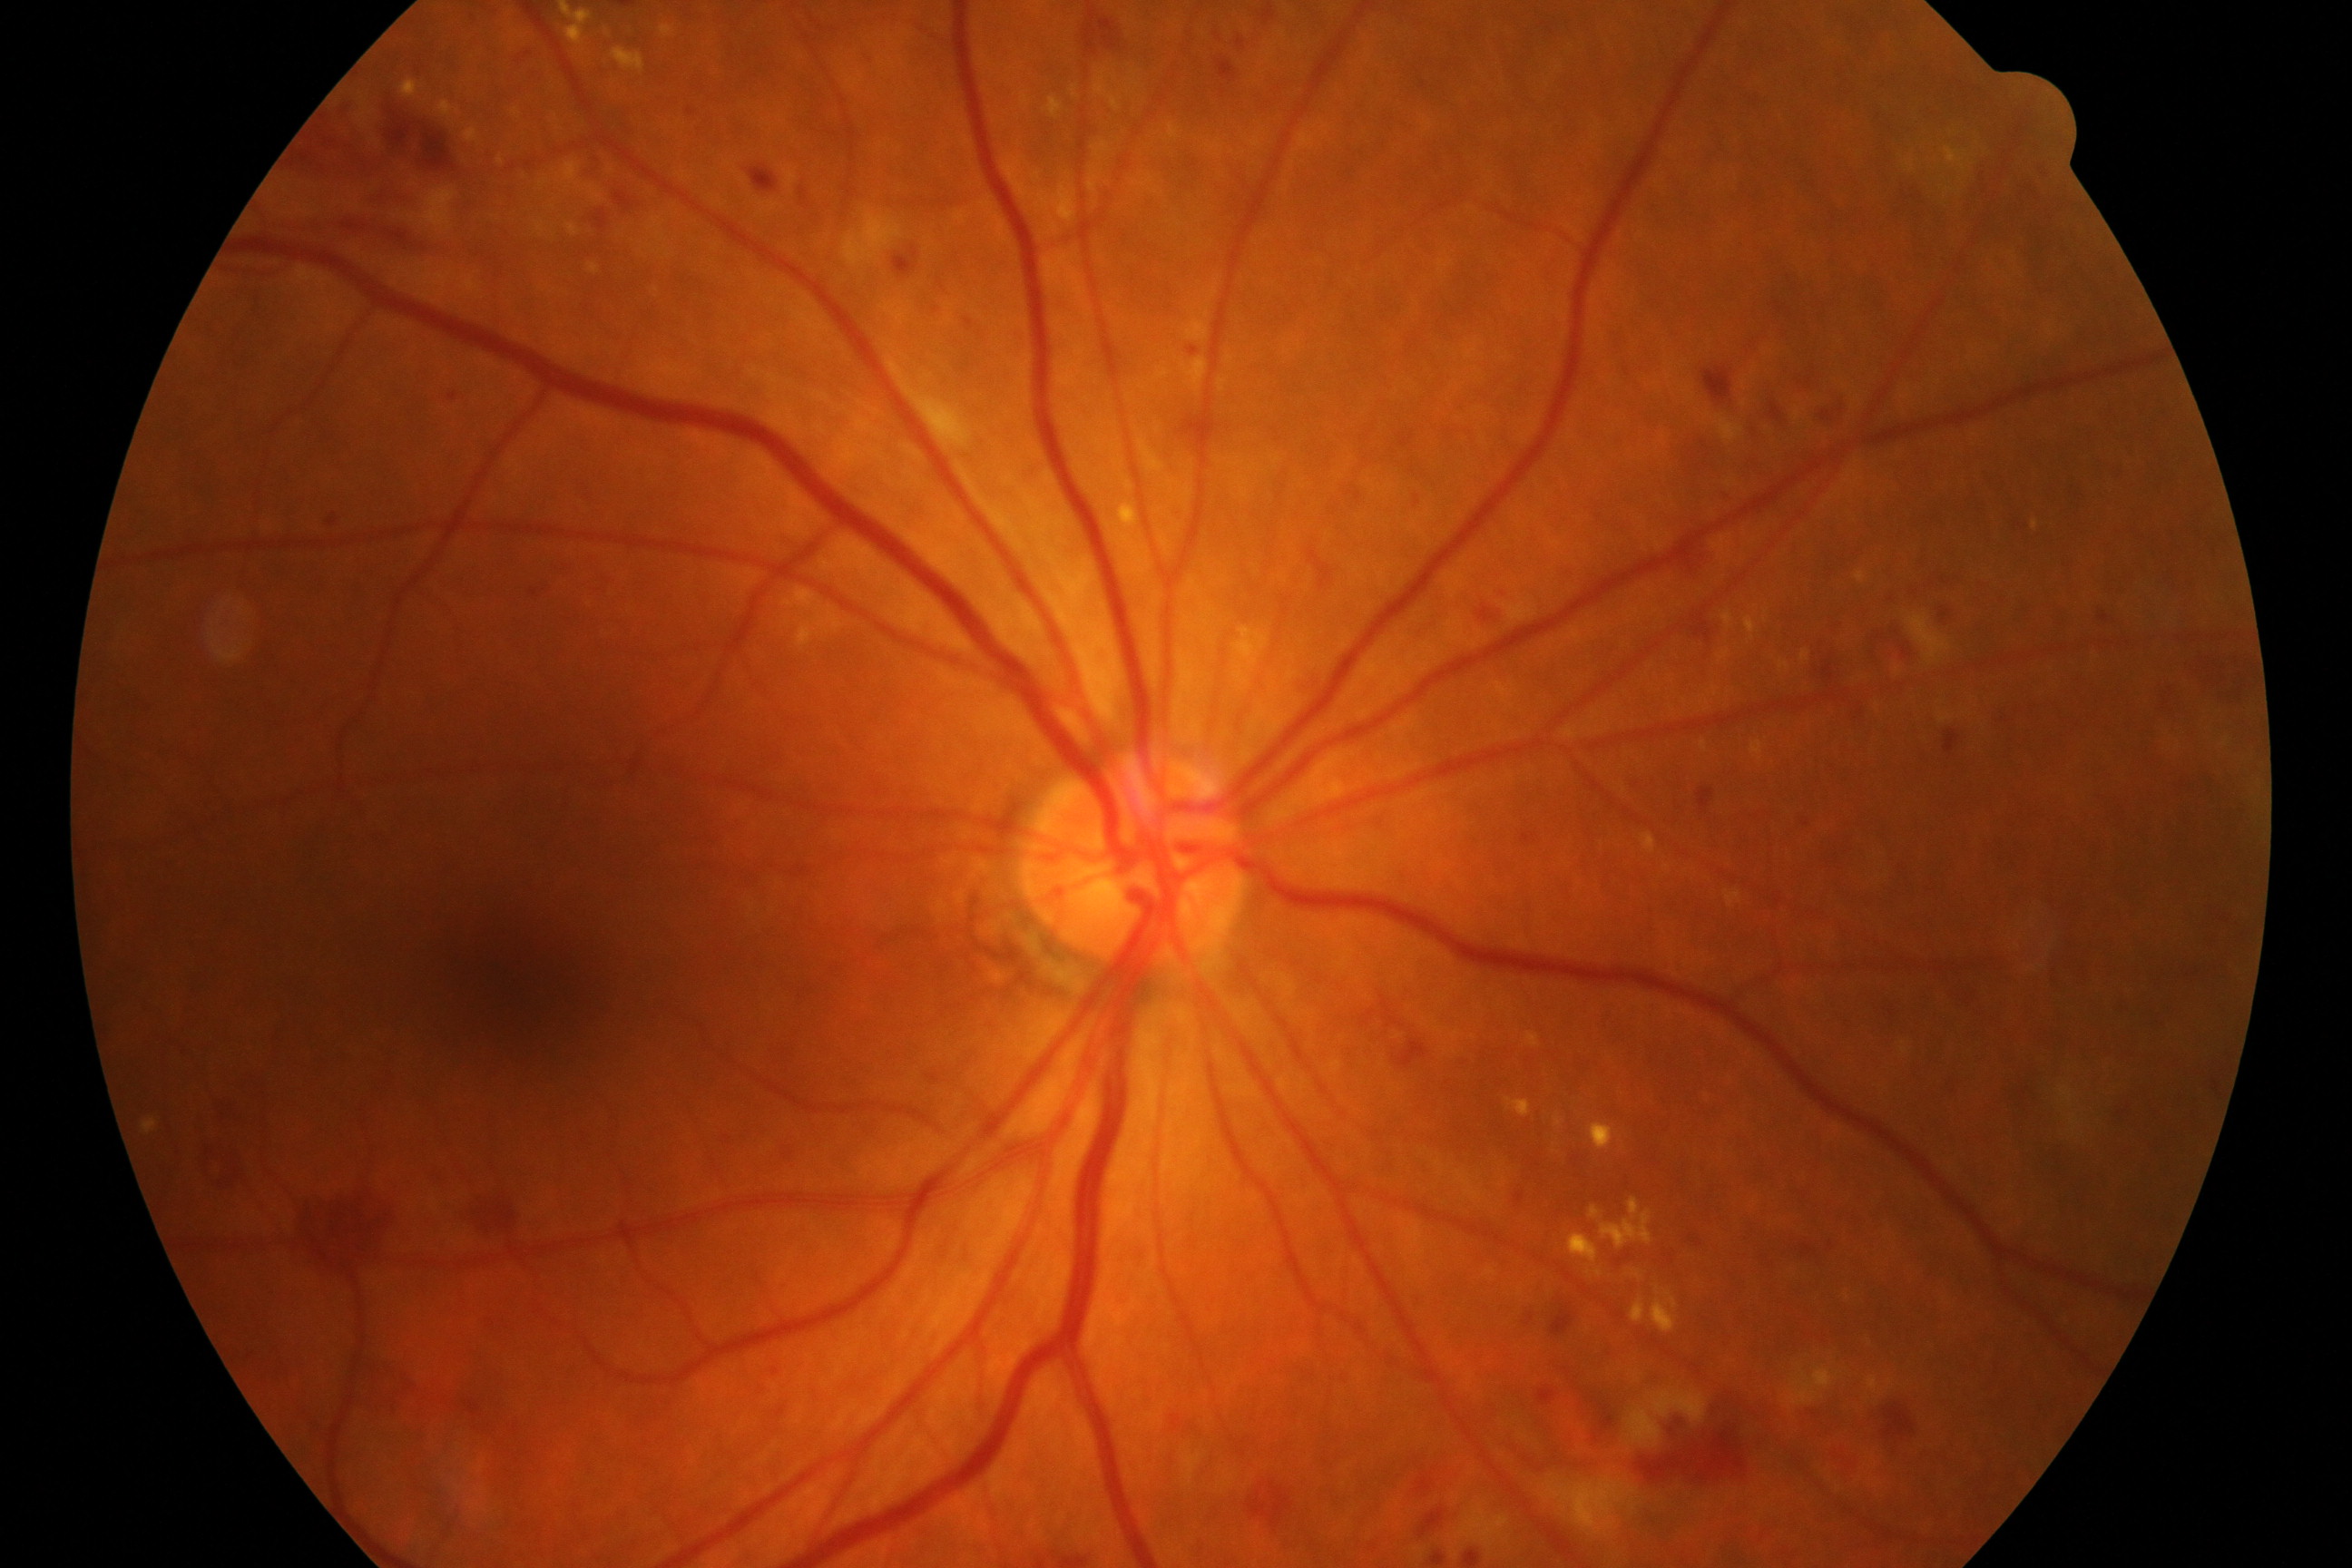 Findings: moderate non-proliferative diabetic retinopathy. Features include microaneurysms with dot and blot hemorrhages or hard exudates, less than severe non-proliferative diabetic retinopathy, and/or with diabetic macular edema.